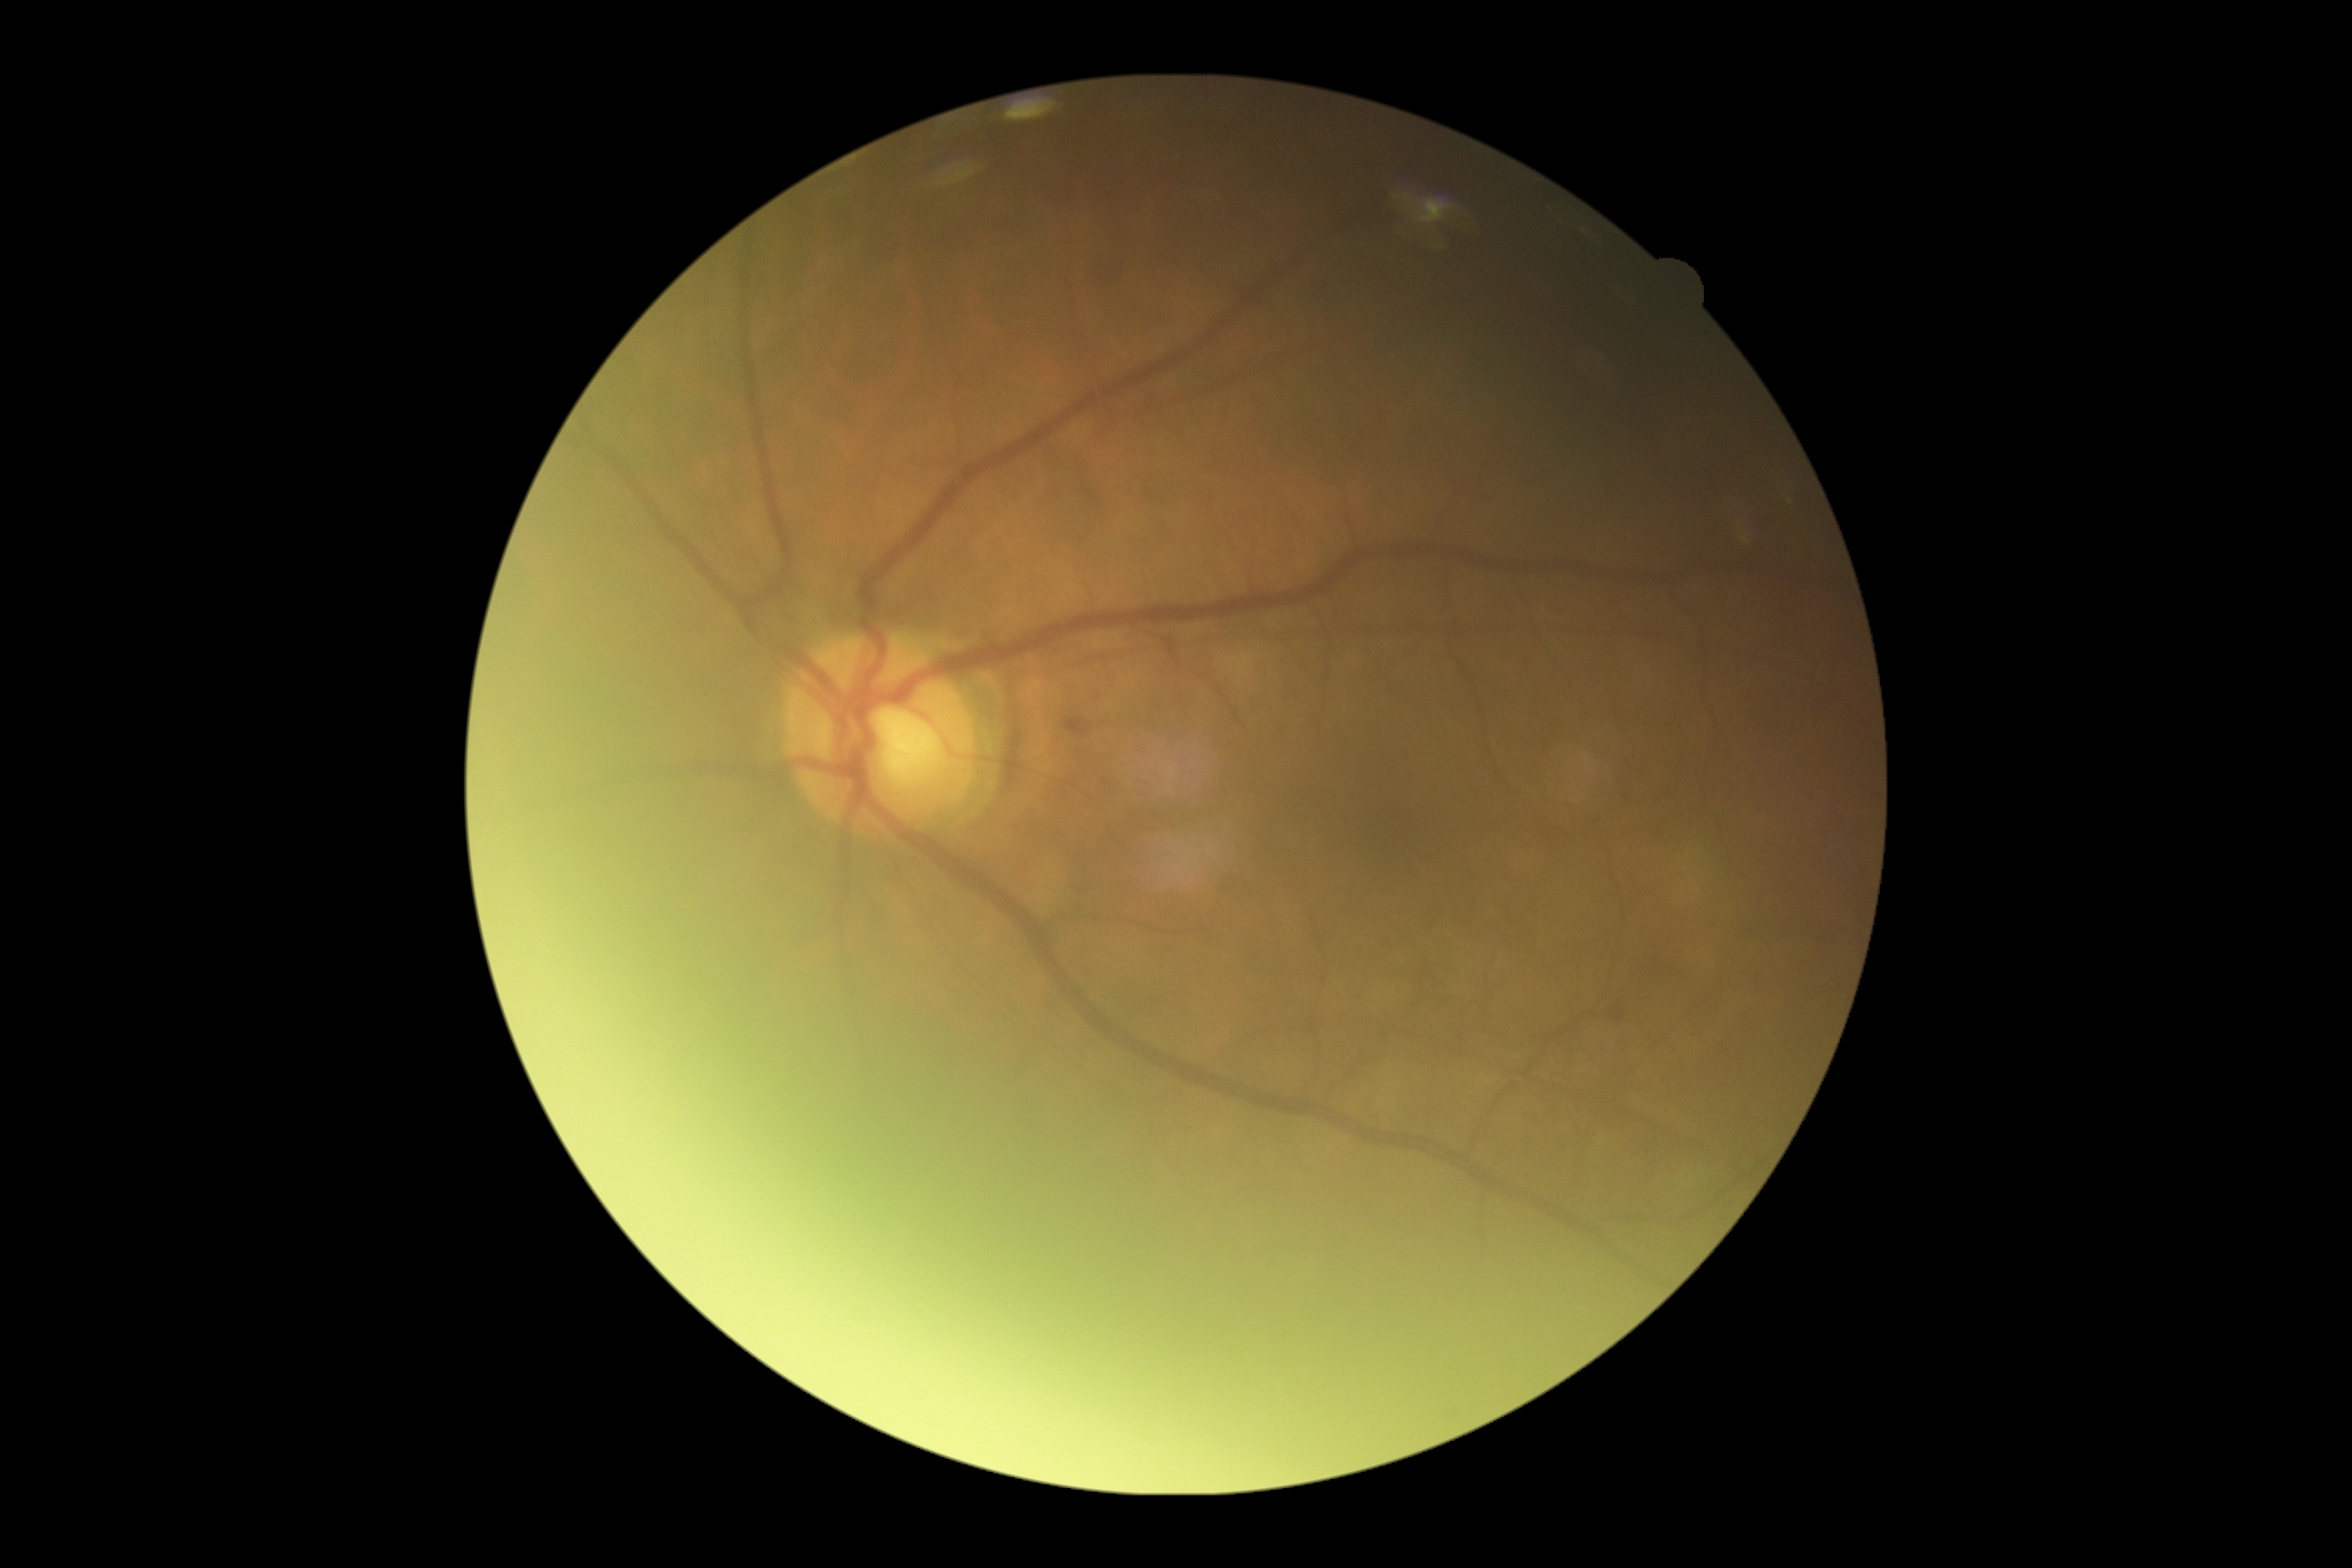
Findings:
* retinopathy — 2